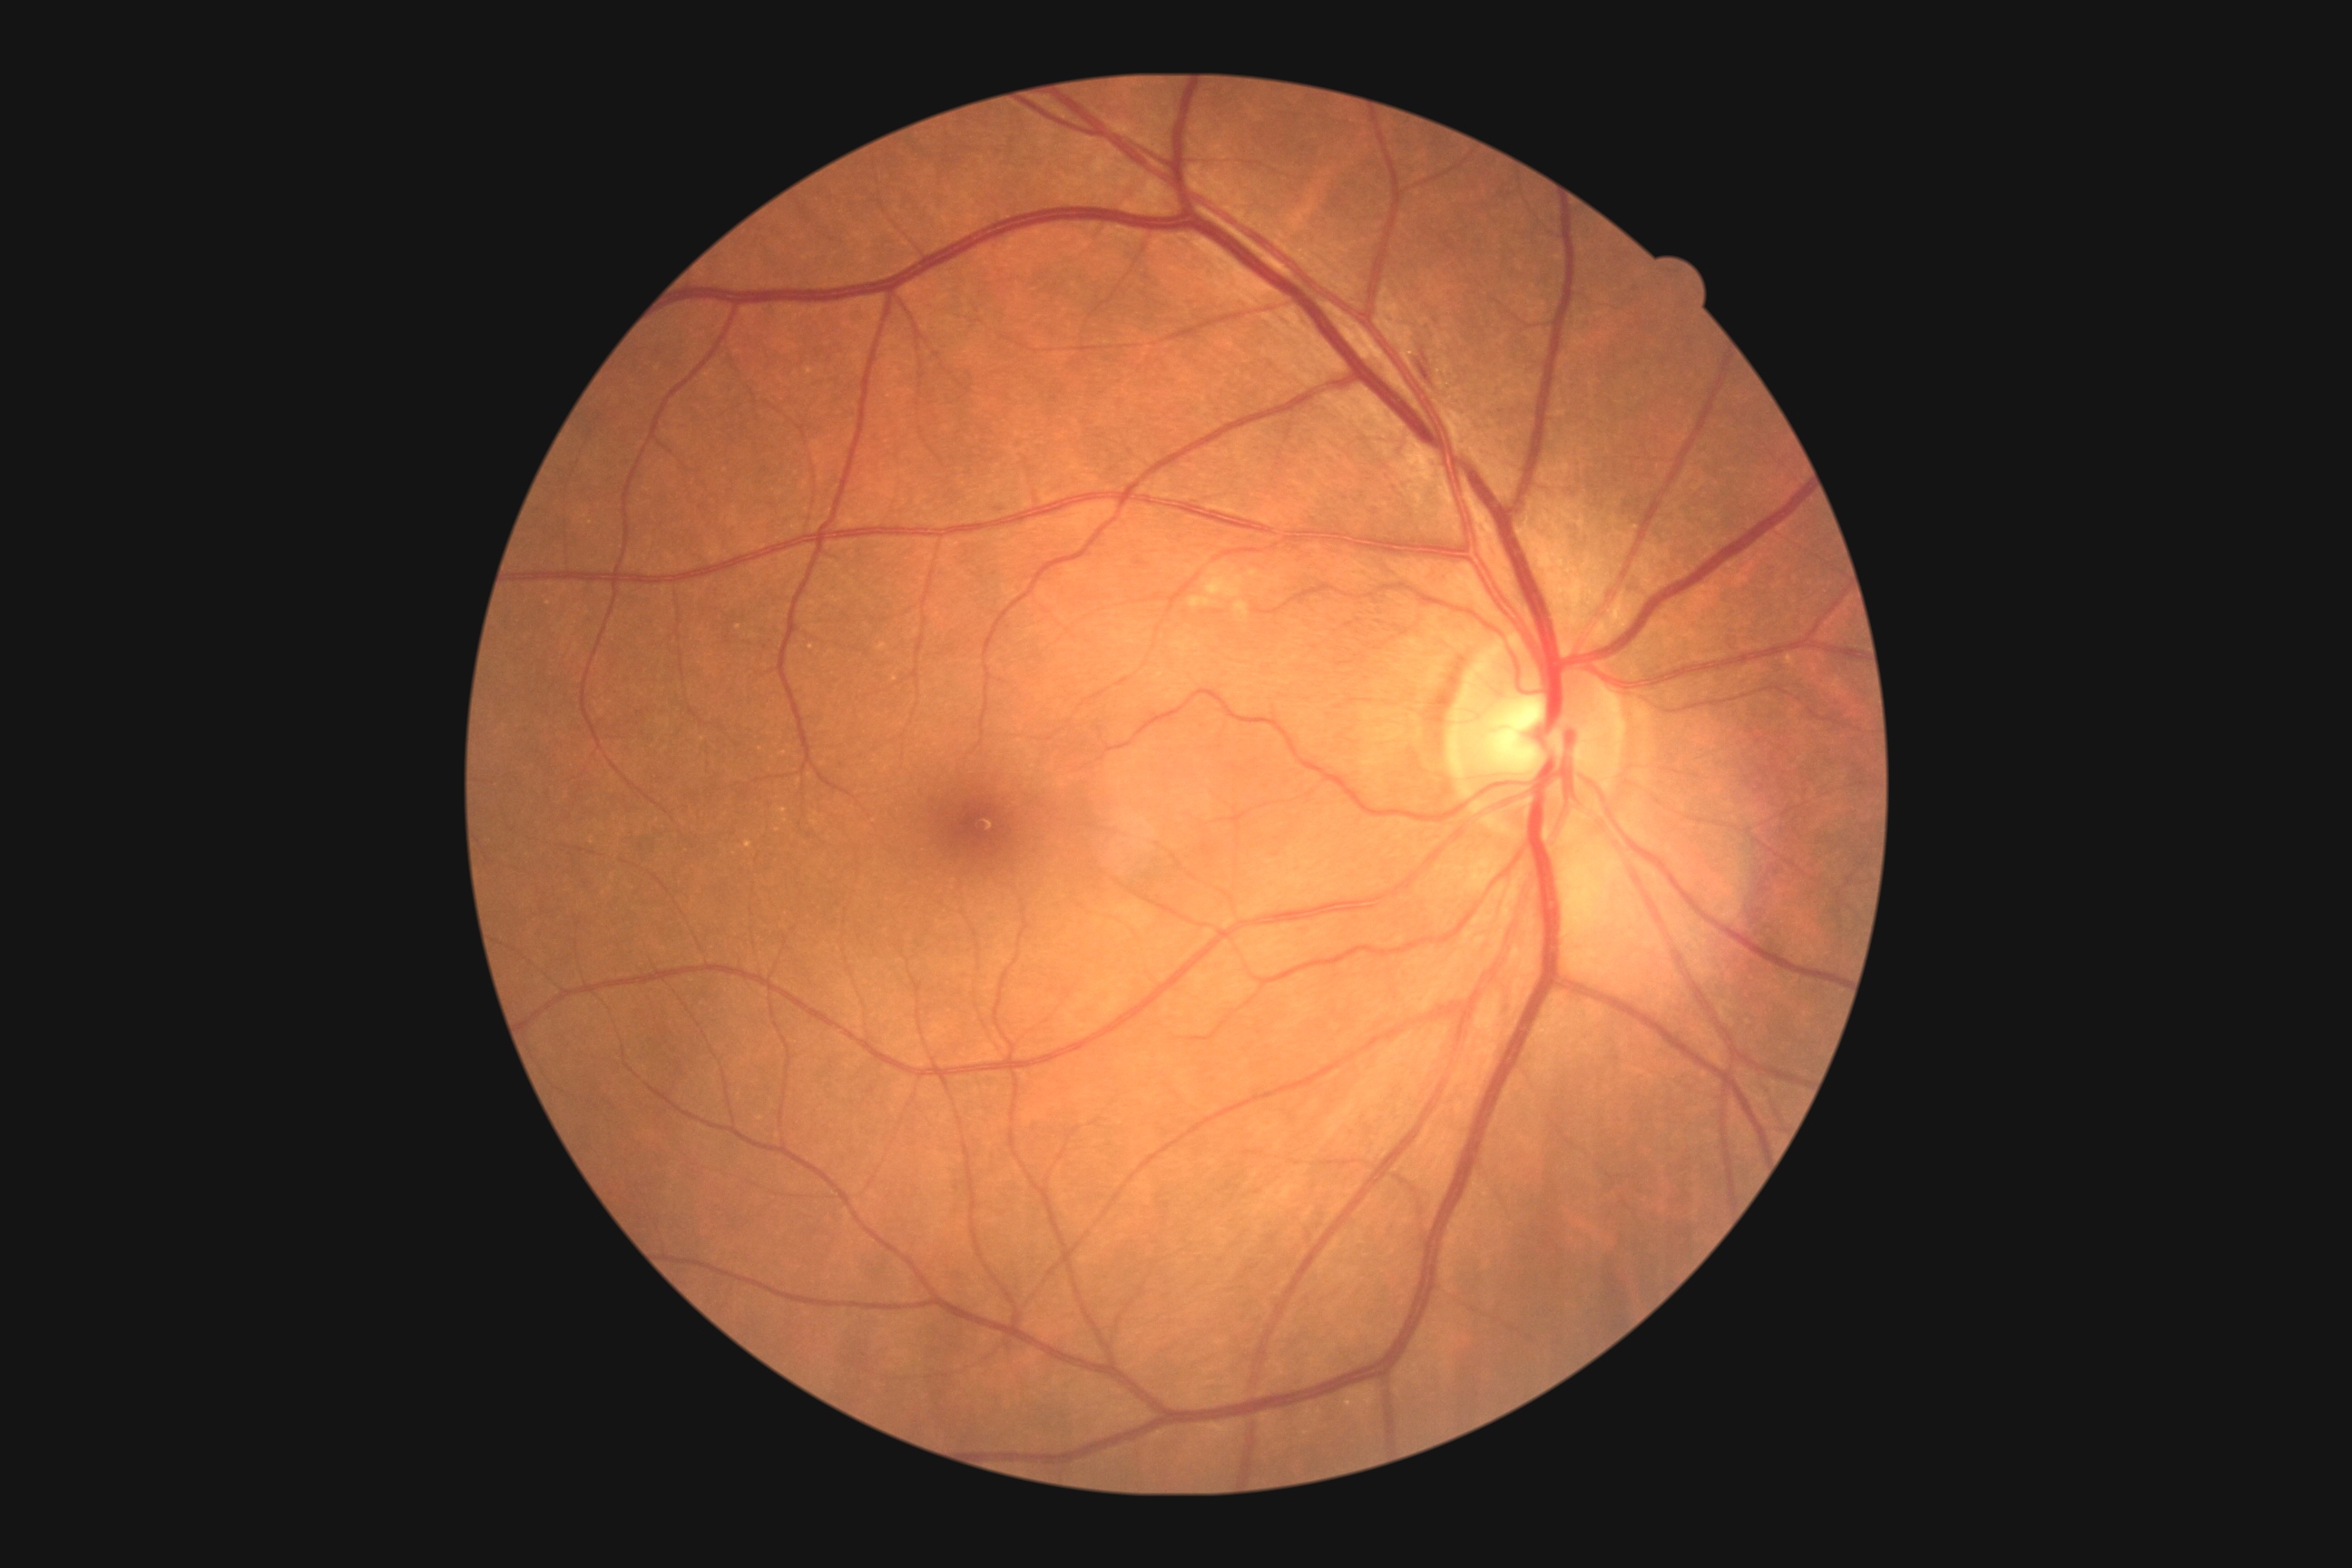 diabetic retinopathy (DR): moderate non-proliferative diabetic retinopathy (grade 2).